1924x1556, UWF retinal mosaic:
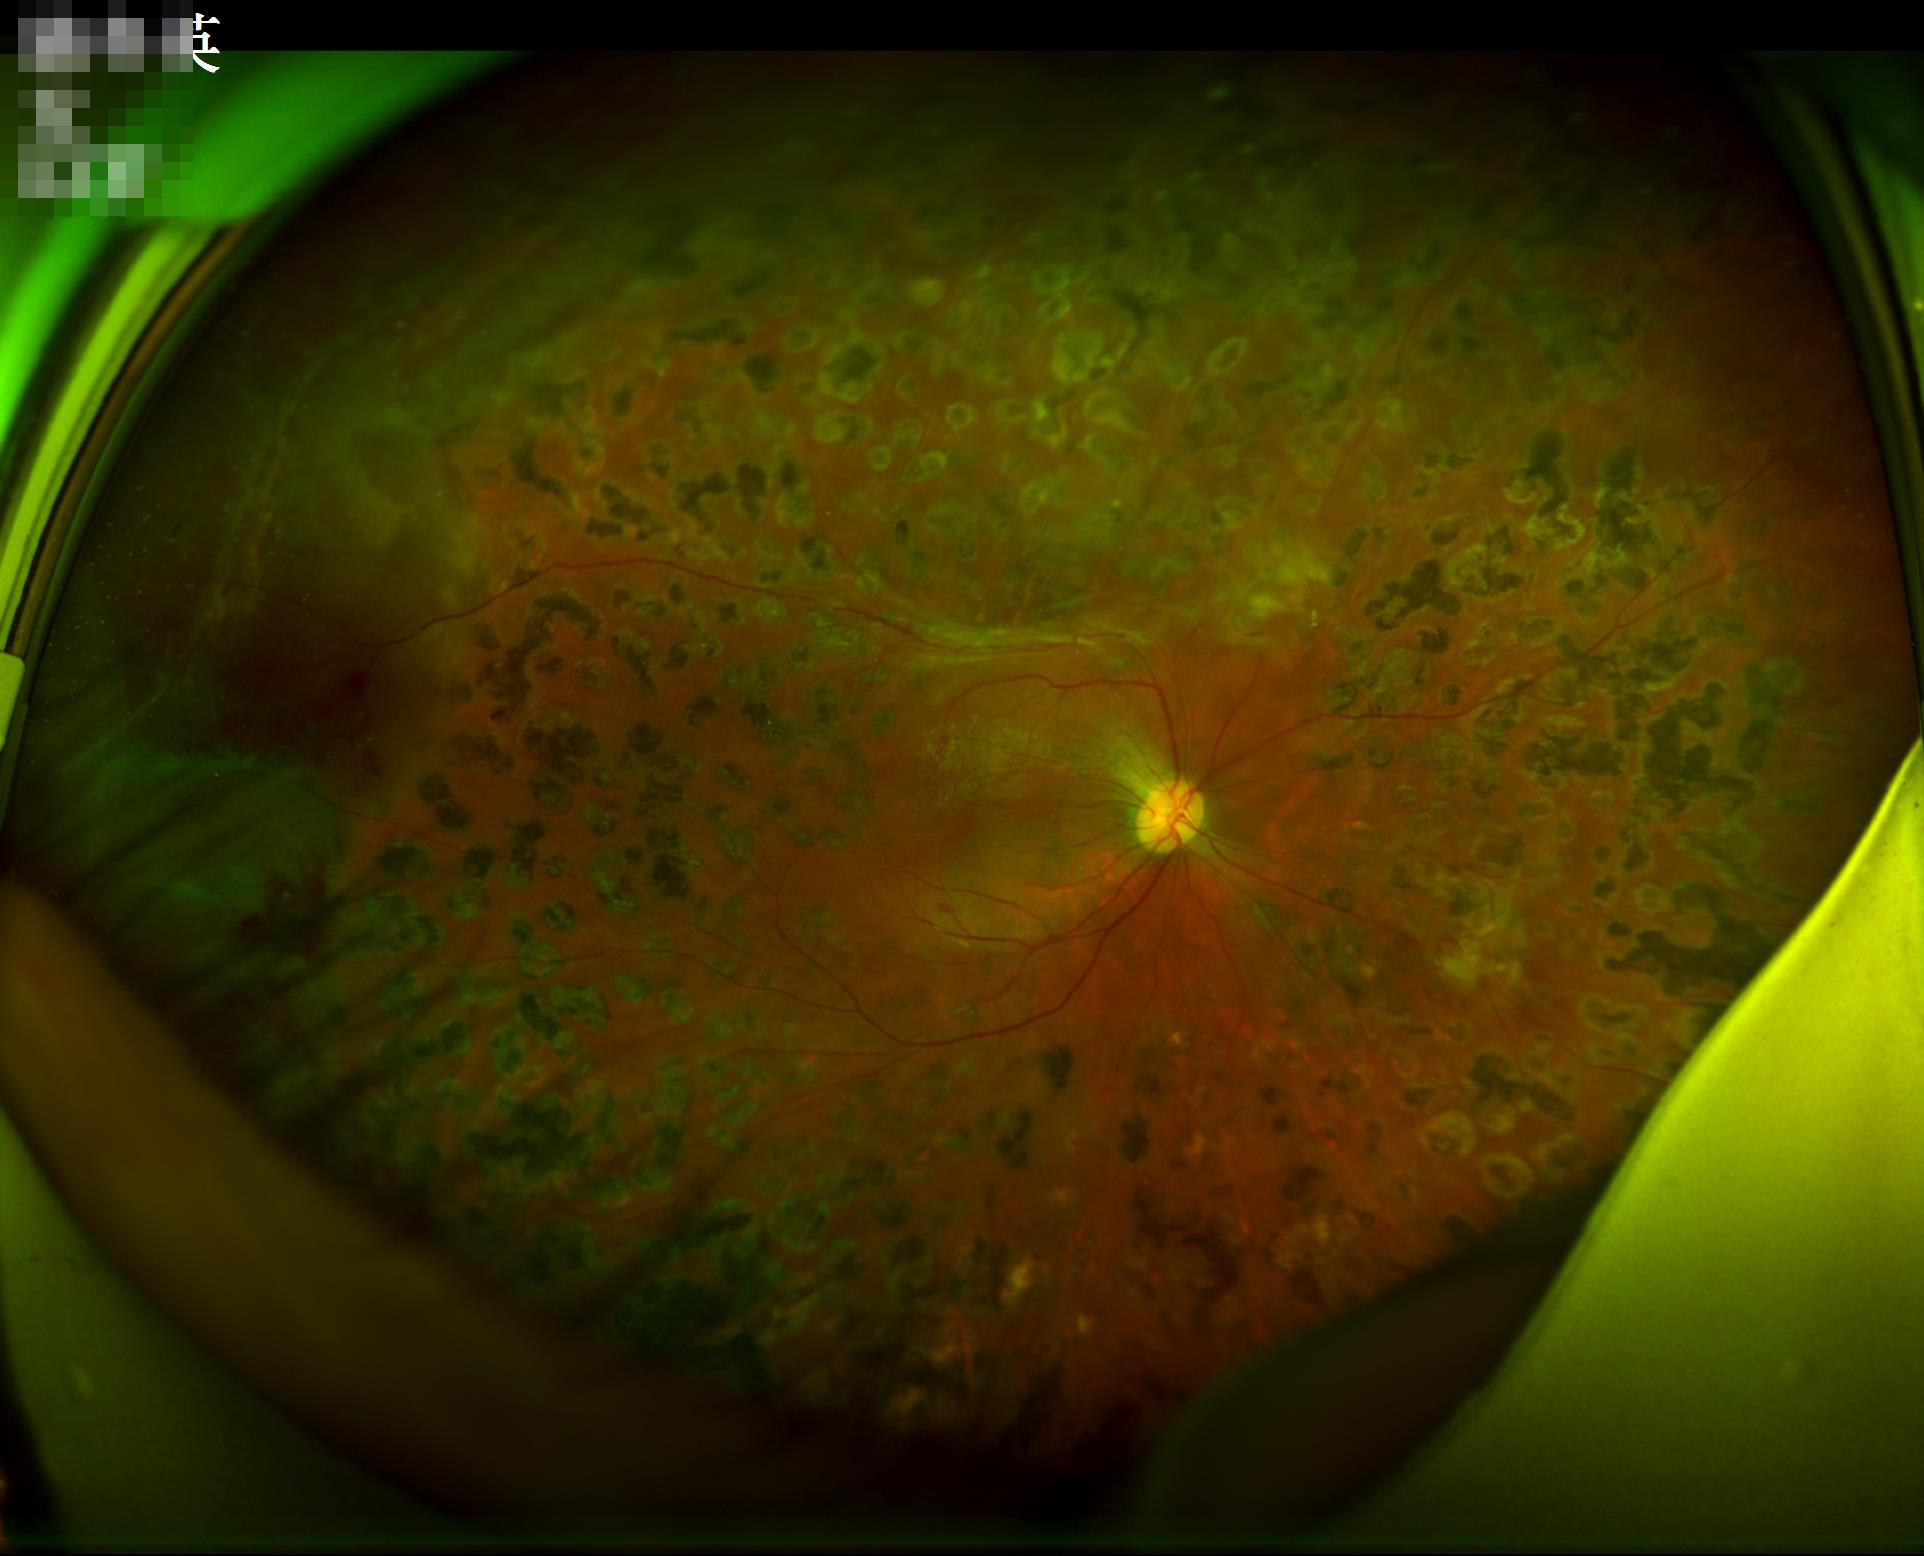
Overall: good, gradable | Contrast: vessels and details readily distinguishable | Focus: clear with no noticeable blur | Illumination: over- or under-exposed.